Image size 2212x1659.
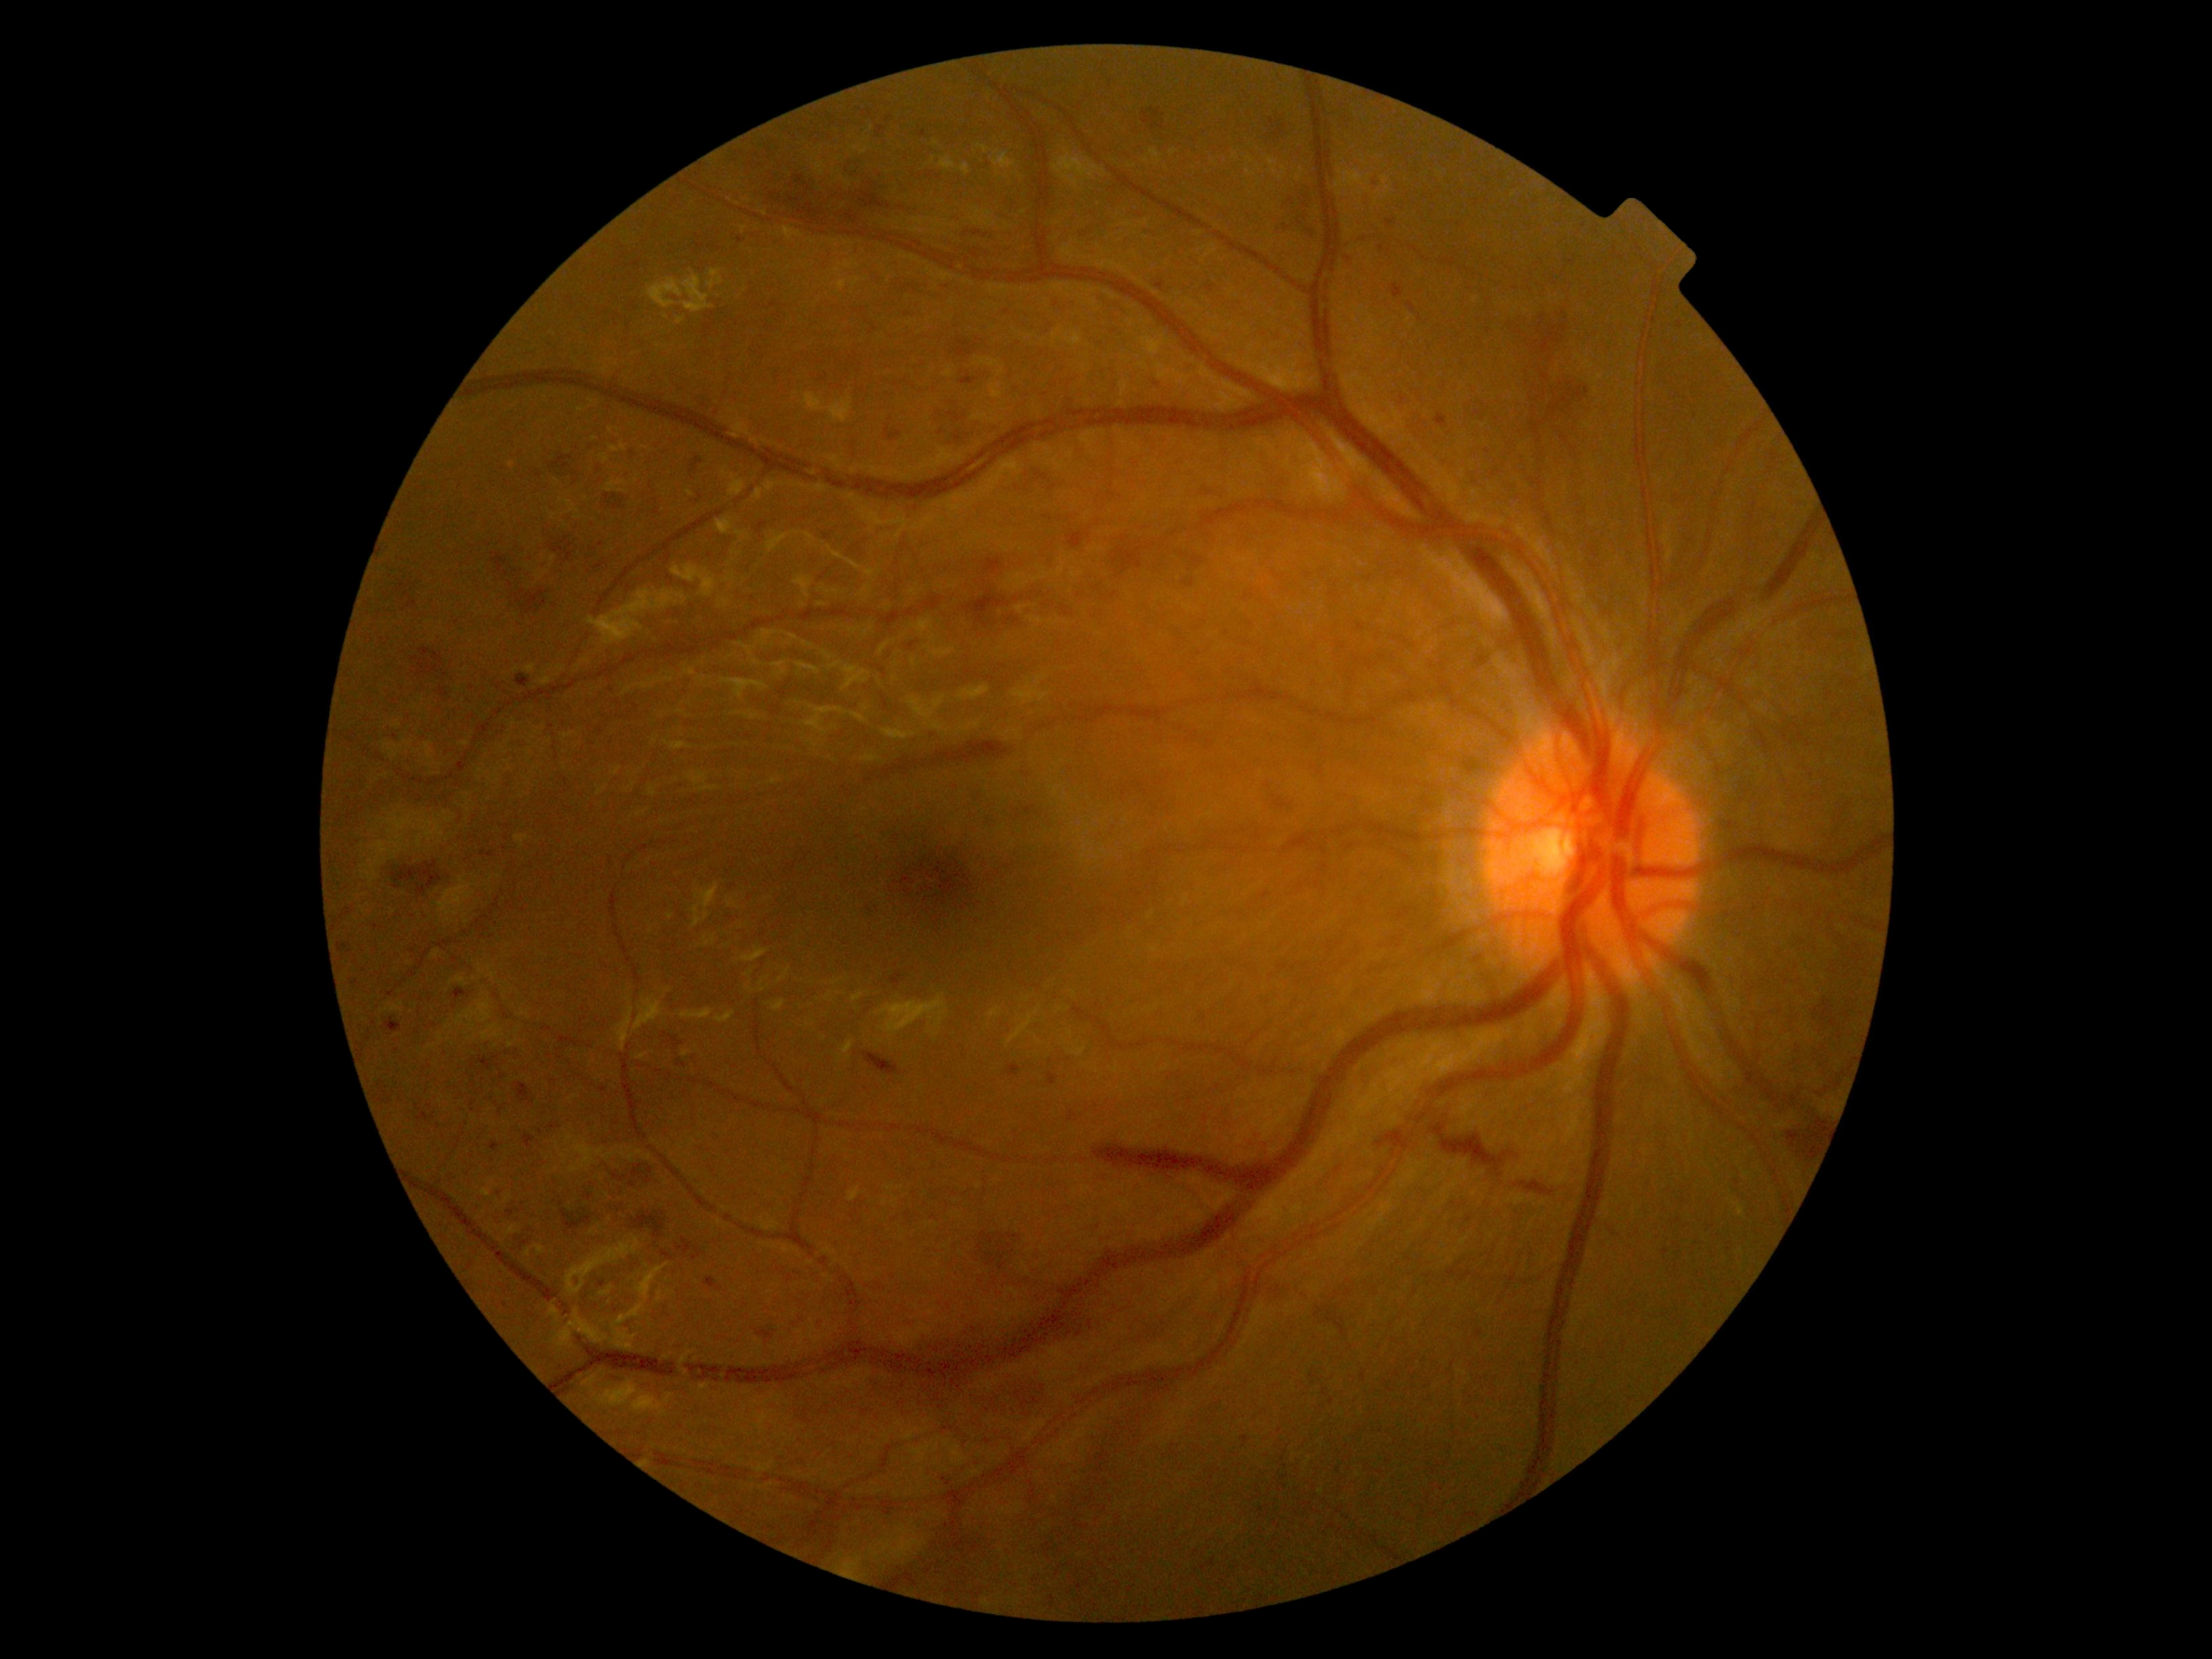 Retinopathy: grade 3 — more than 20 intraretinal hemorrhages in each of 4 quadrants, definite venous beading in 2 or more quadrants, or prominent intraretinal microvascular abnormalities in 1 or more quadrants, with no signs of proliferative retinopathy.
Hemorrhages include those at [x1=1779, y1=1111, x2=1832, y2=1166]; [x1=1093, y1=1146, x2=1282, y2=1192]; [x1=1153, y1=379, x2=1168, y2=392]; [x1=1261, y1=112, x2=1294, y2=143]; [x1=677, y1=1058, x2=687, y2=1069]; [x1=971, y1=249, x2=979, y2=260]; [x1=524, y1=1134, x2=535, y2=1149]; [x1=626, y1=261, x2=640, y2=269]; [x1=396, y1=581, x2=411, y2=593]; [x1=562, y1=1208, x2=592, y2=1231]; [x1=384, y1=1019, x2=402, y2=1033]; [x1=1473, y1=403, x2=1493, y2=424].
Additional small hemorrhages near [896,839]; [602,1284]; [1007,312]; [946,287]; [633,1185]; [1245,1439]; [395,737].